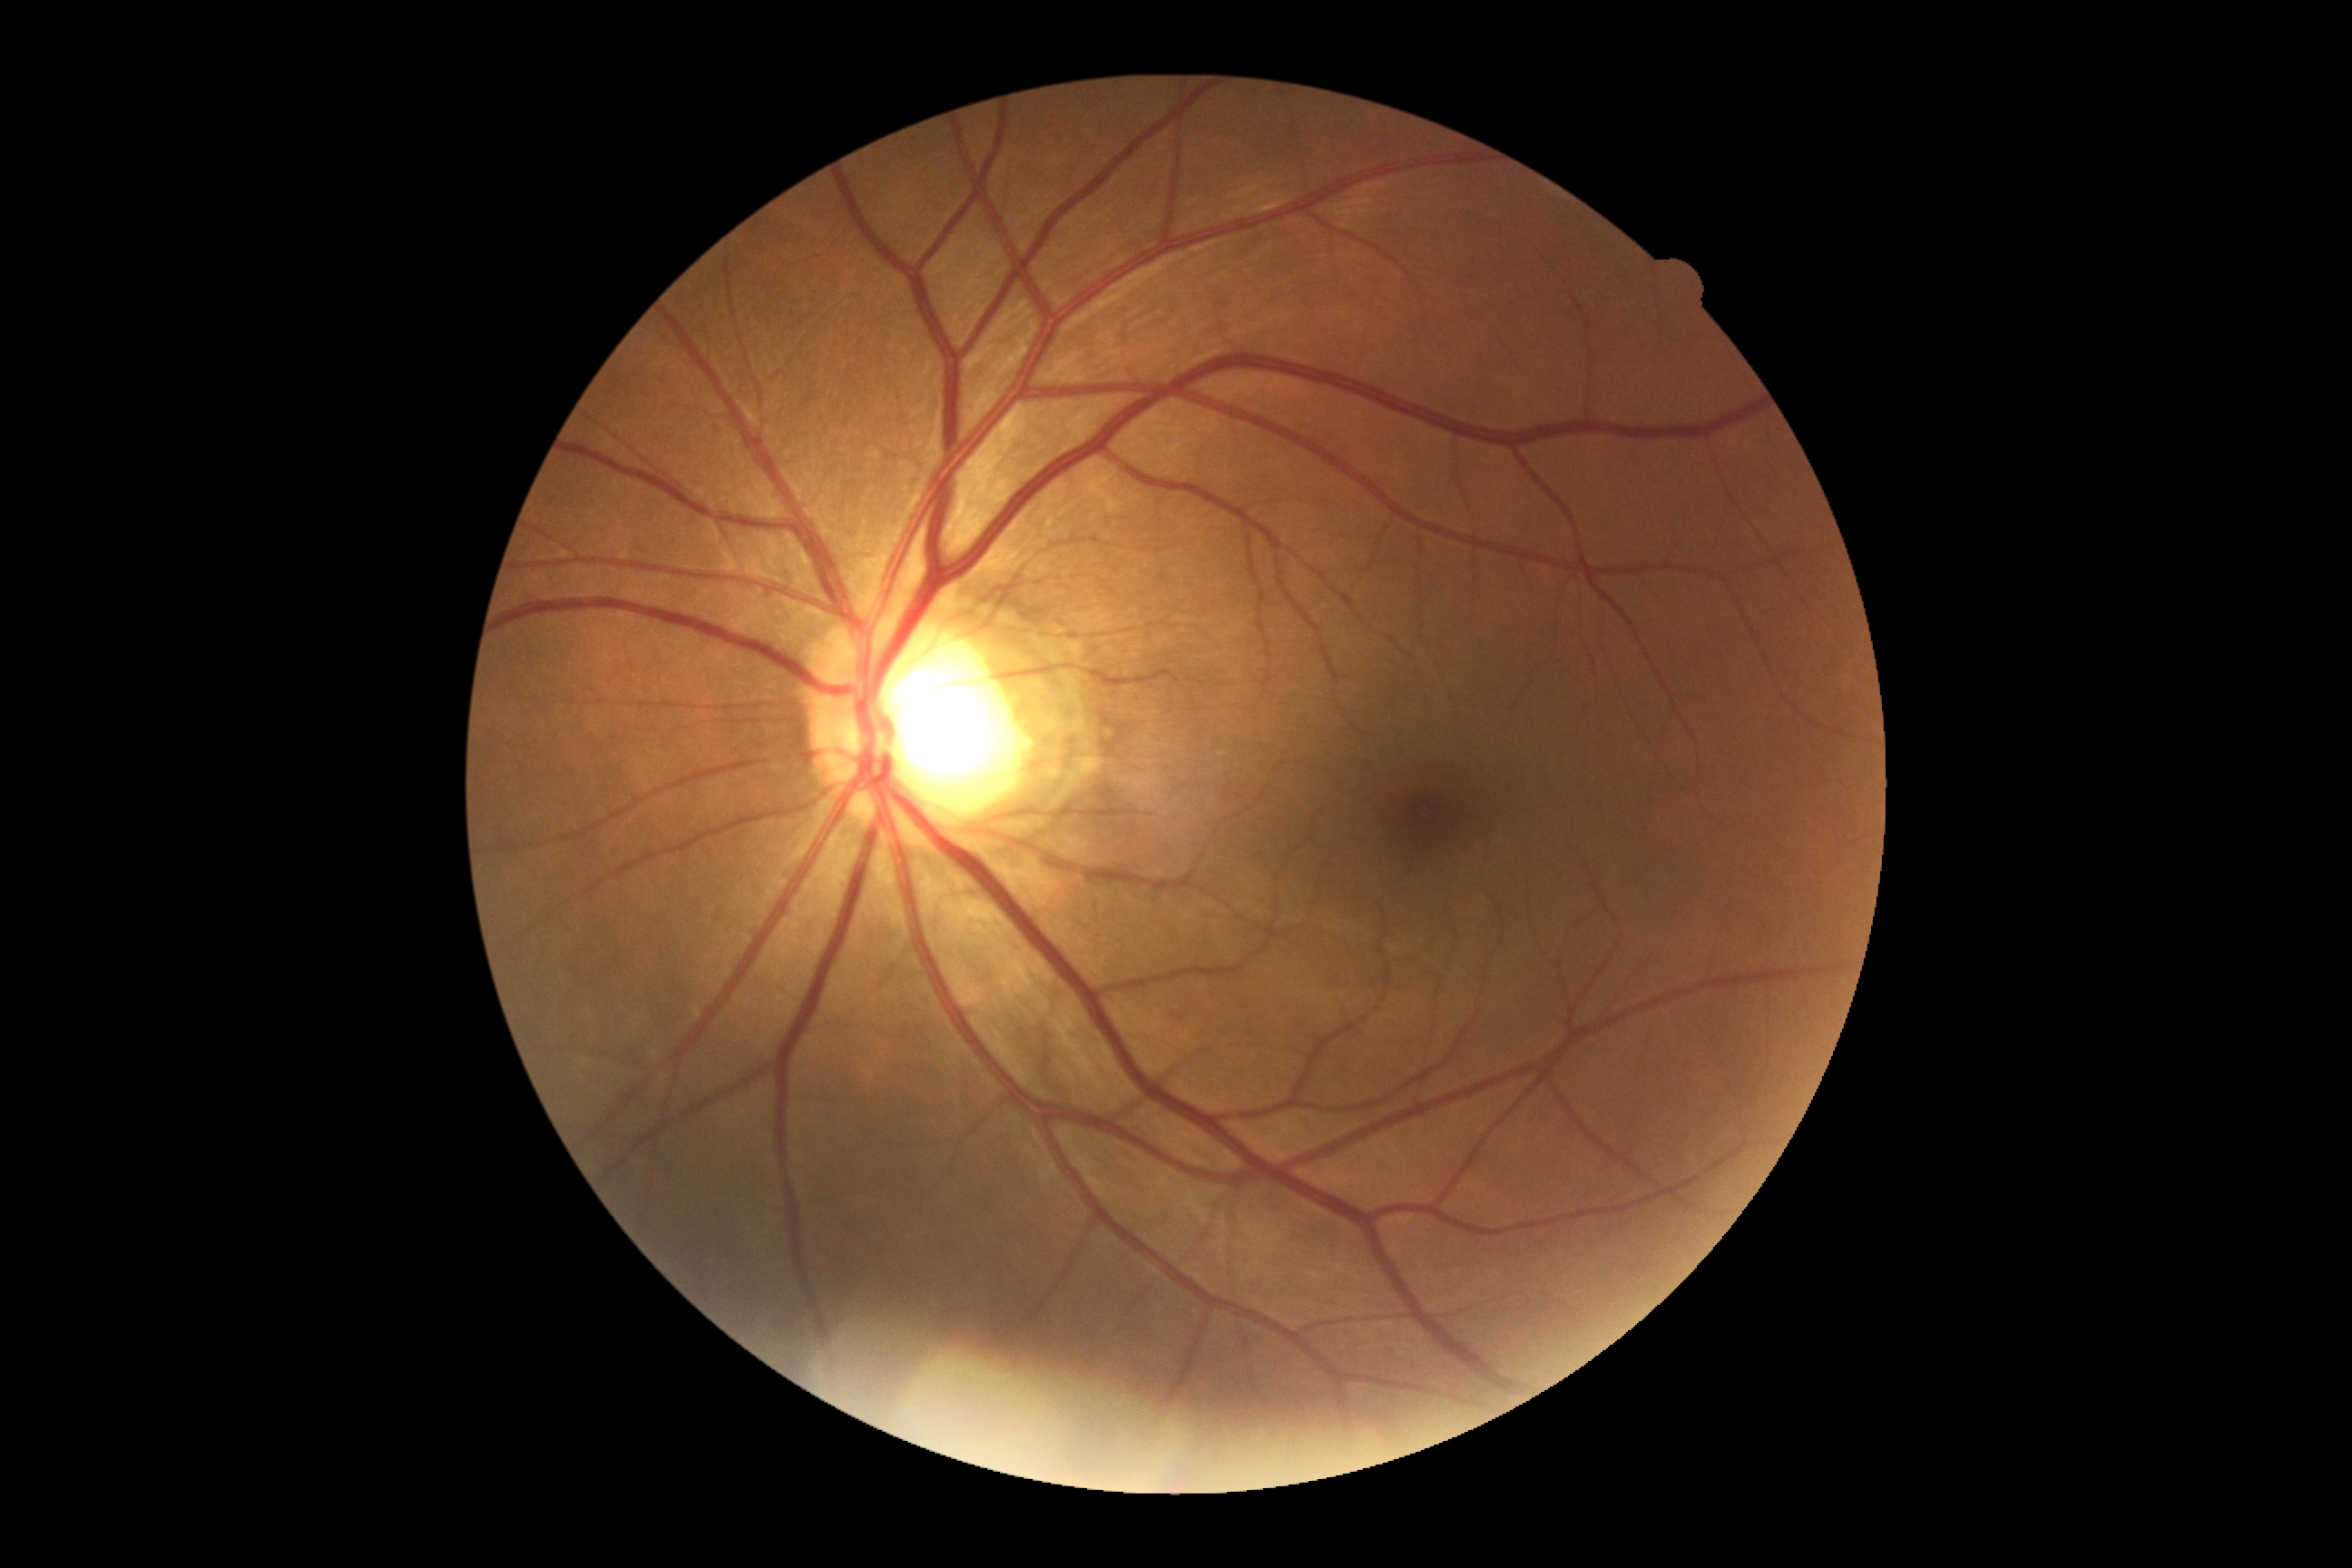 DR severity@grade 0 (no apparent retinopathy) — no visible signs of diabetic retinopathy; DR impression@no DR findings.